Nonmydriatic fundus photograph; retinal fundus photograph — 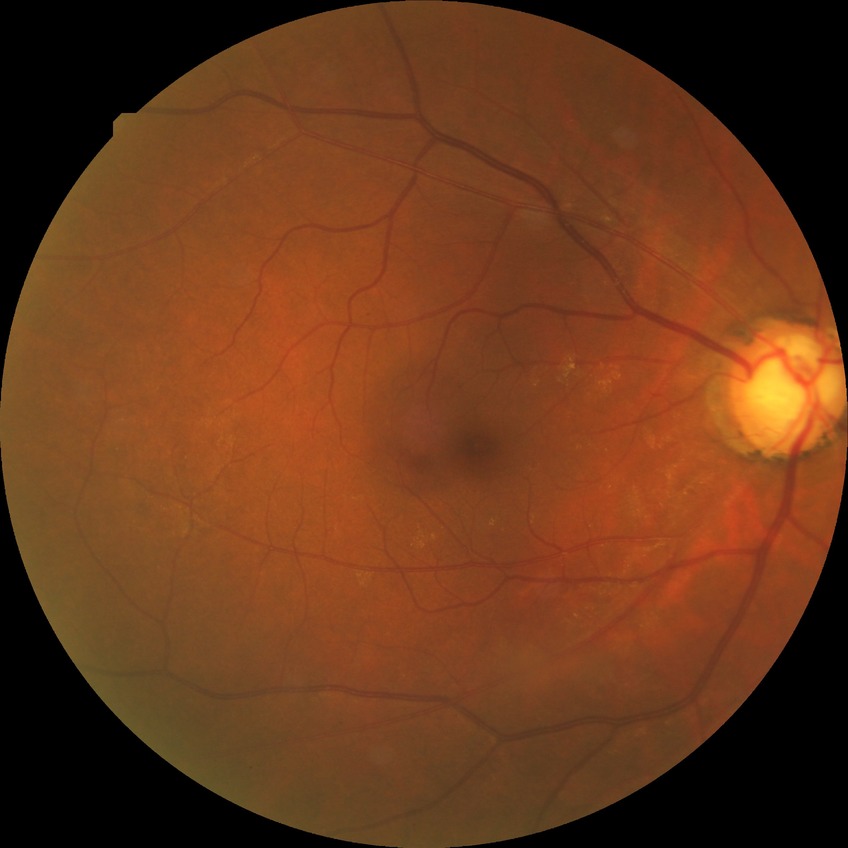 Diabetic retinopathy (DR) is no diabetic retinopathy (NDR).